Retinal fundus photograph, FOV: 45 degrees, 2352 x 1568 pixels — 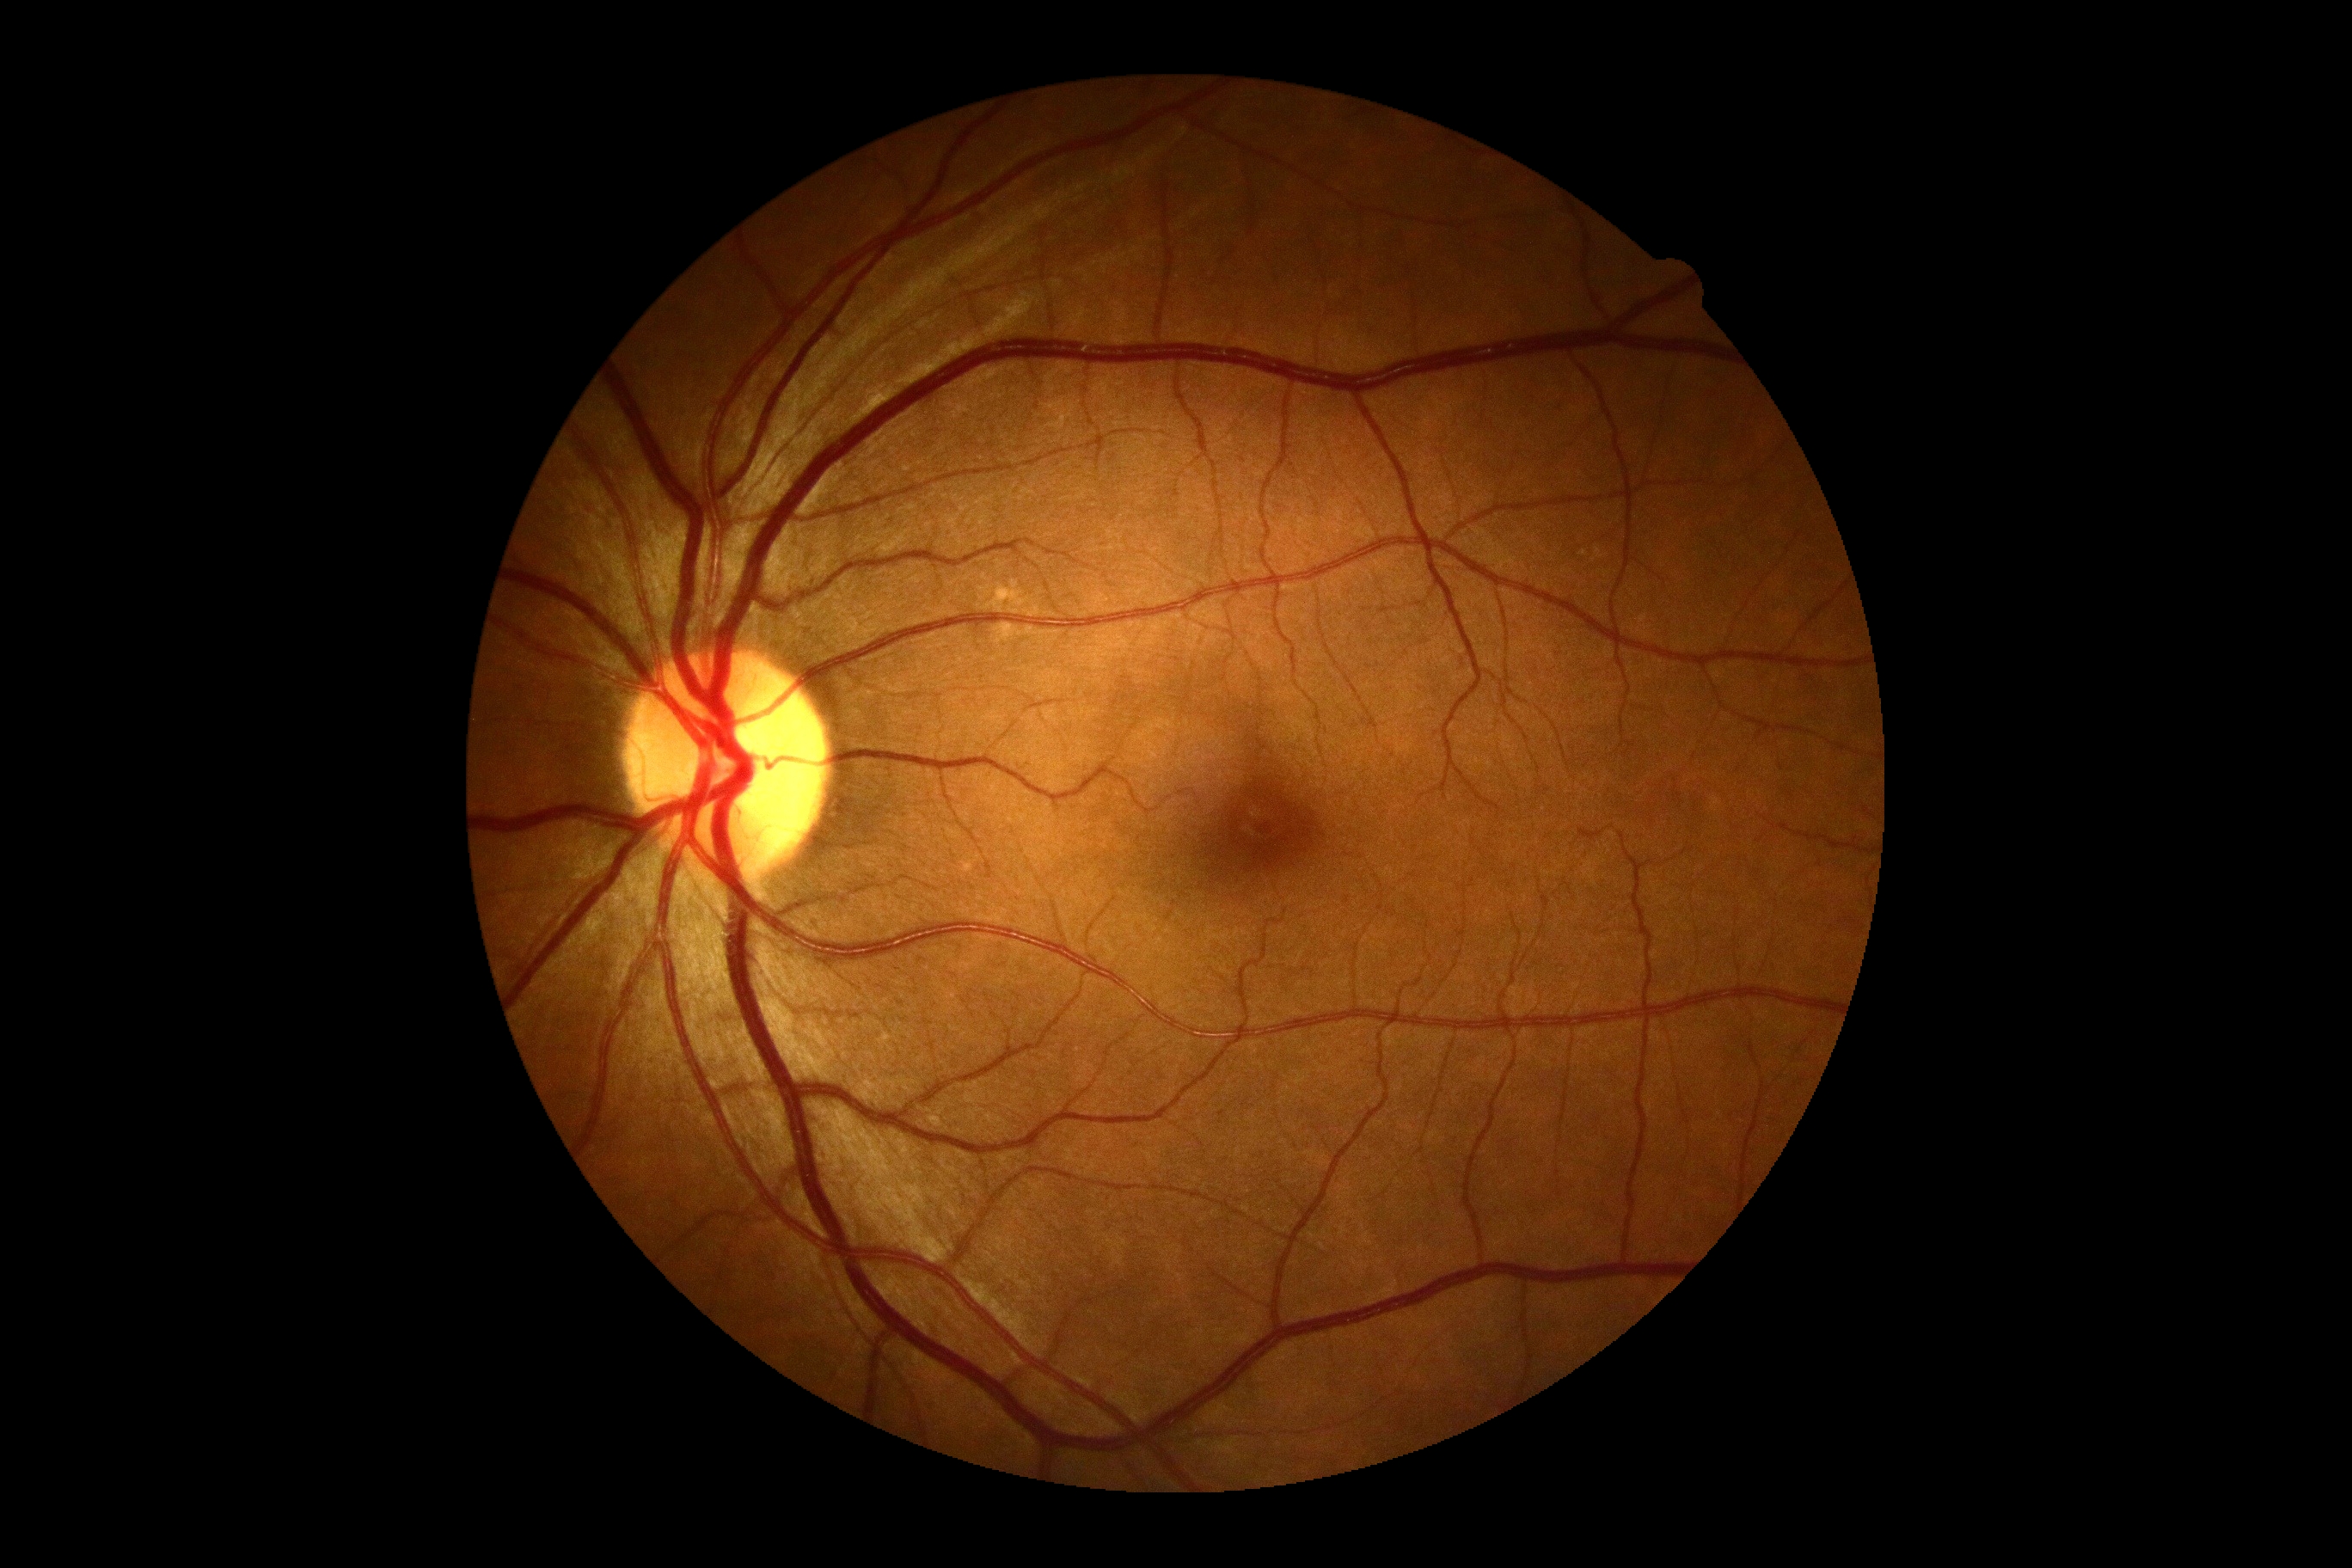

Findings:
- diabetic retinopathy (DR) — grade 0 (no apparent retinopathy)
- DR impression — no apparent DR